45° FOV — 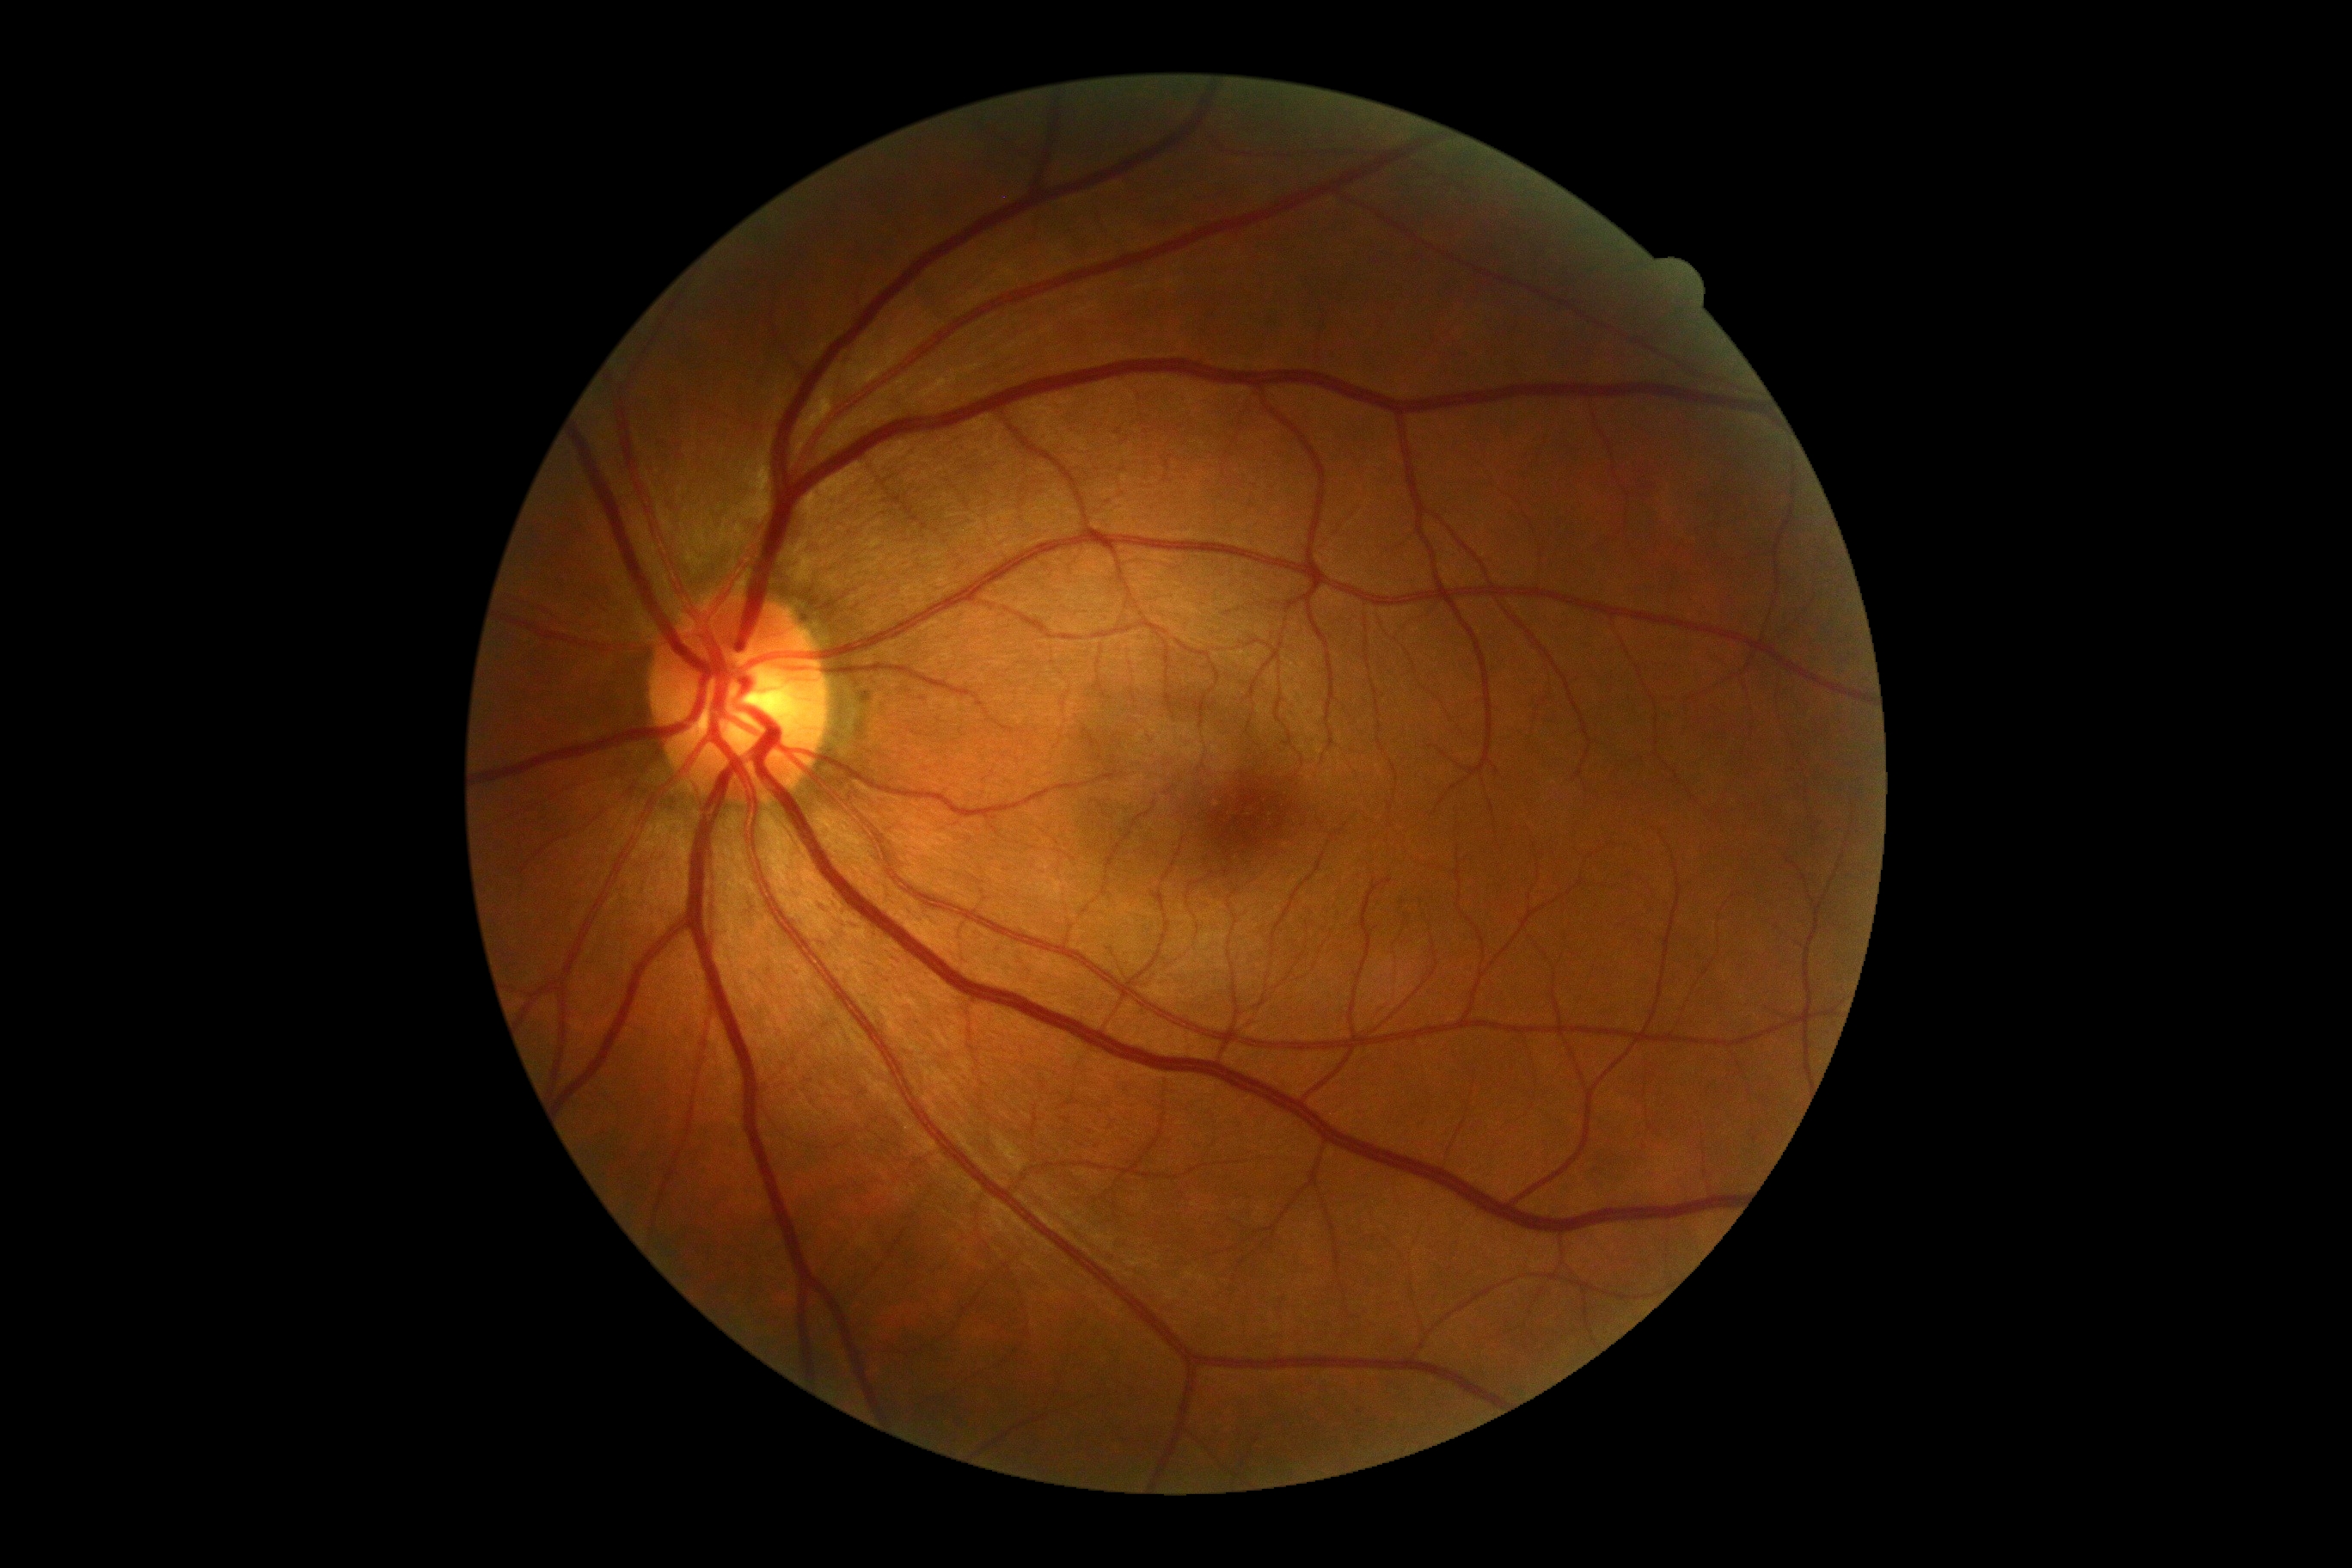

No DR findings.
Diabetic retinopathy (DR): 0/4.